2352x1568 · 45° field of view
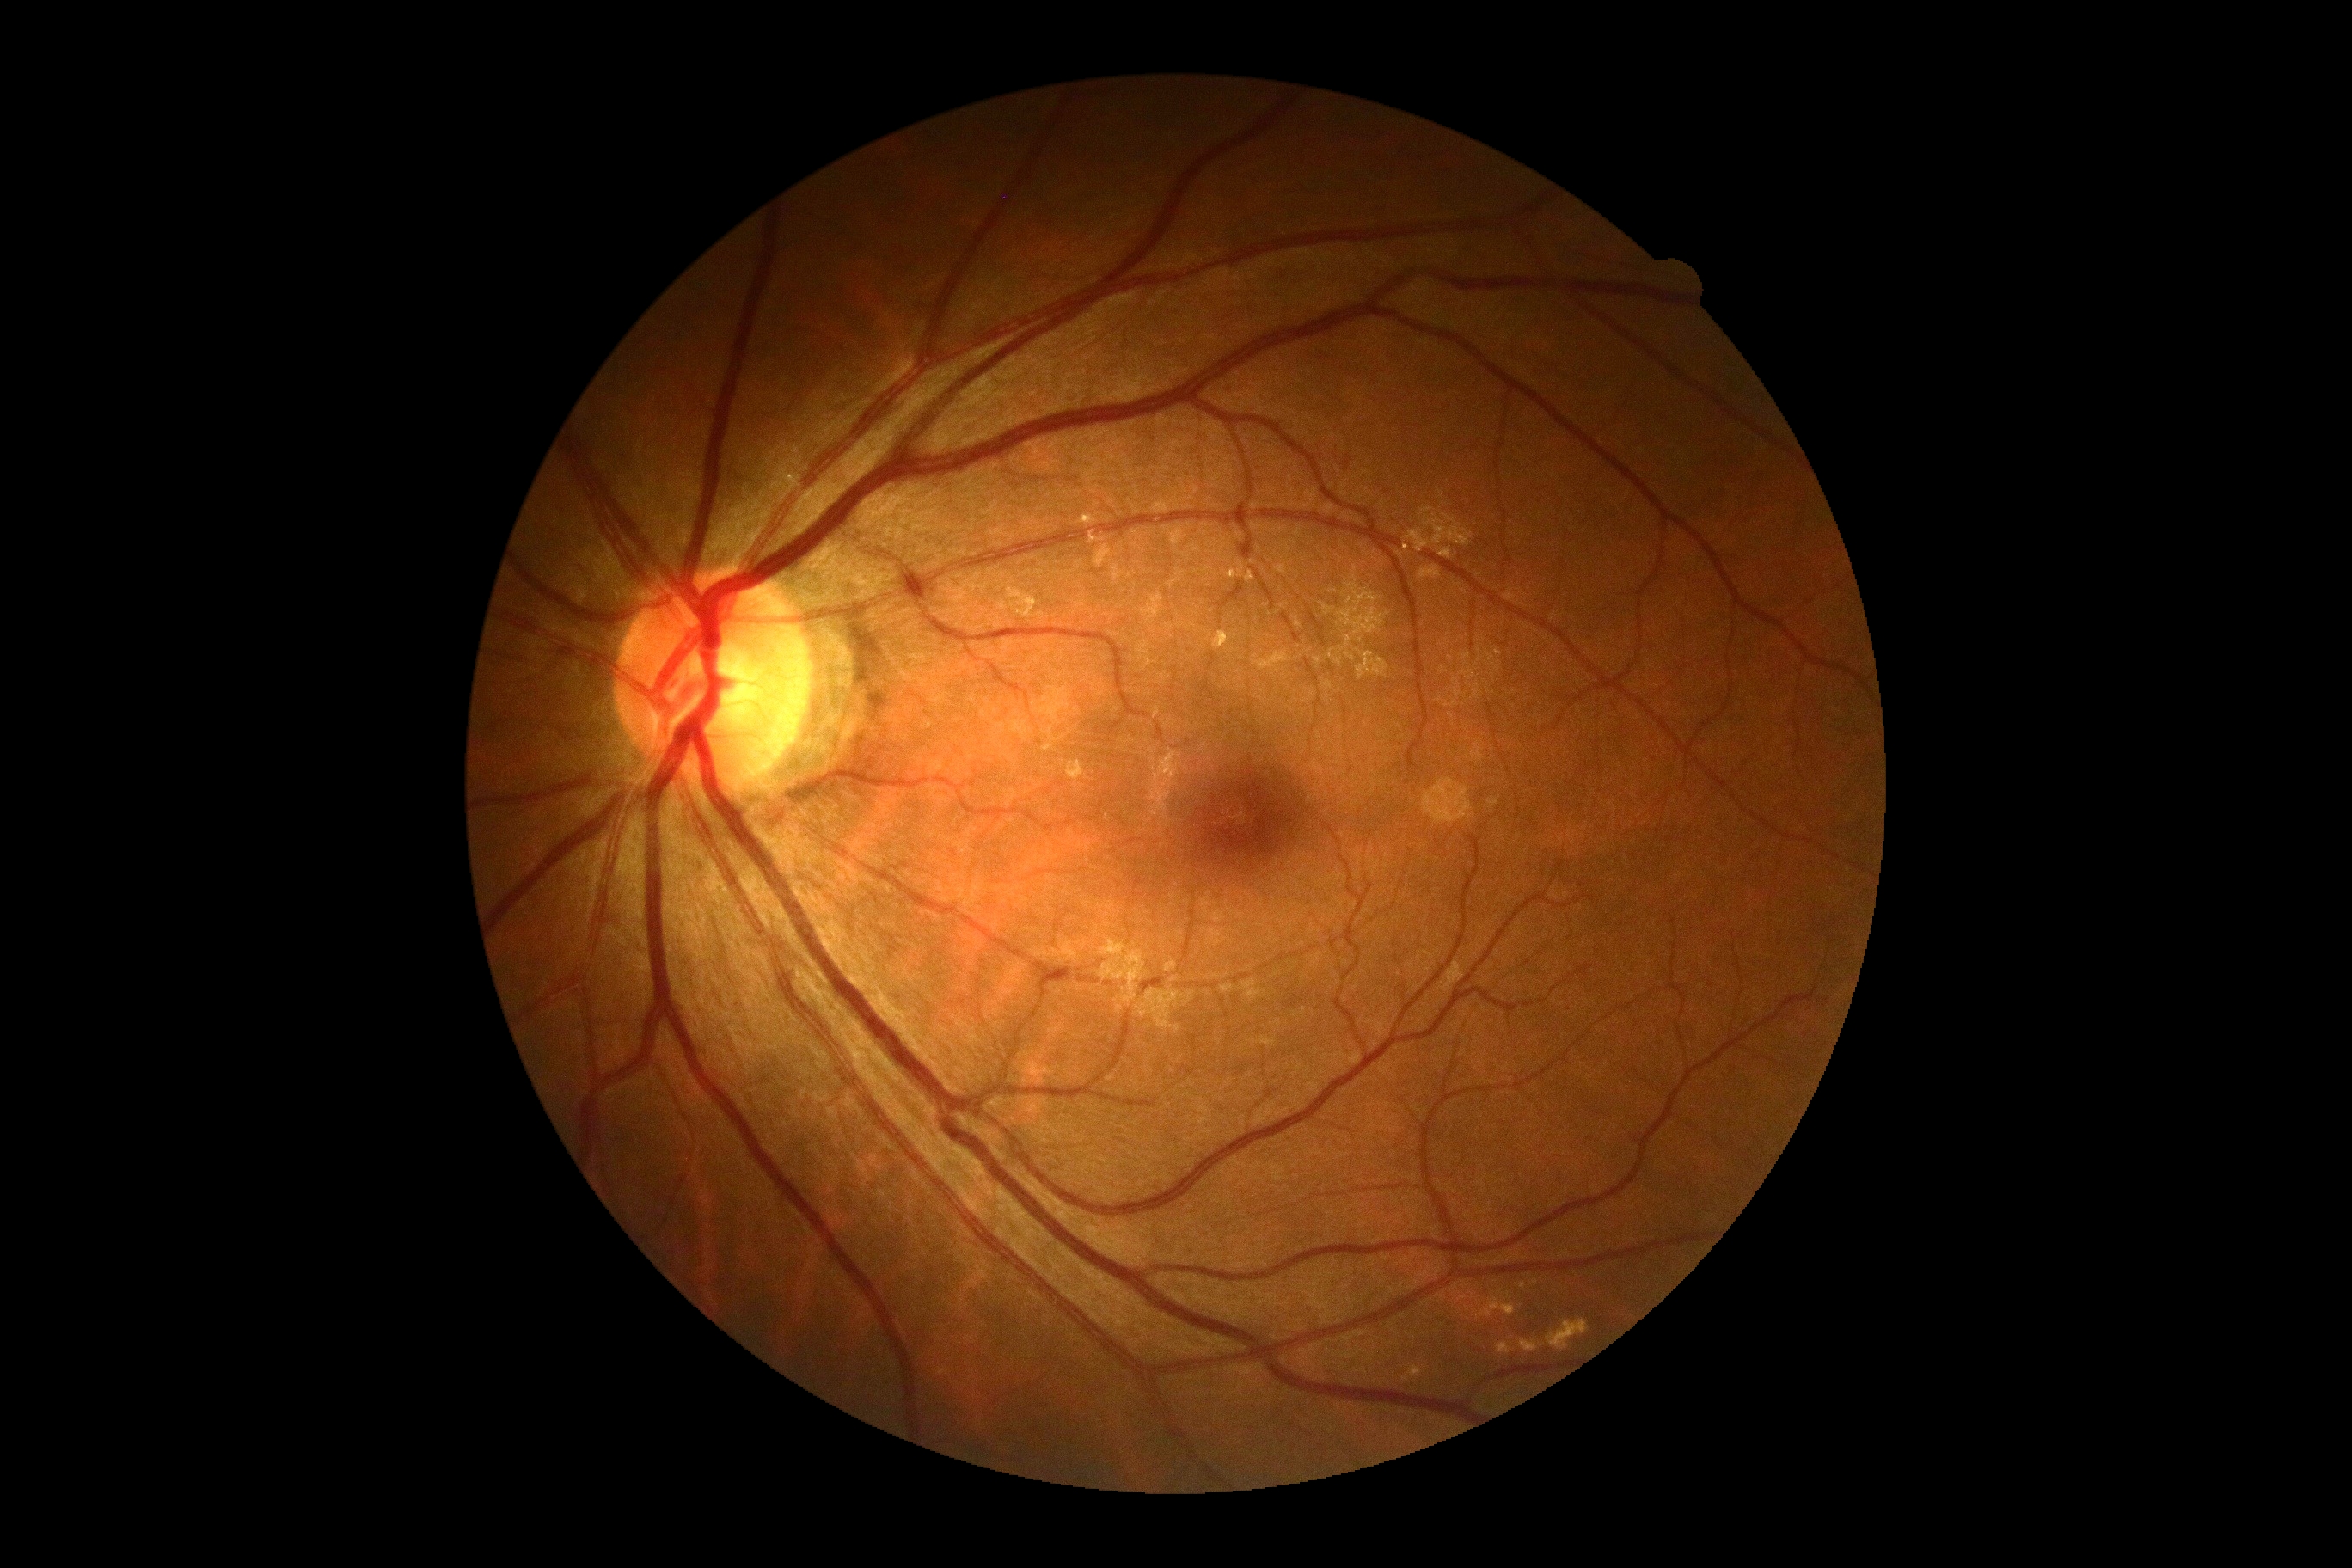

DR severity=0/4 — no visible signs of diabetic retinopathy; DR impression=negative for DR.